45 degree fundus photograph · retinal fundus photograph:
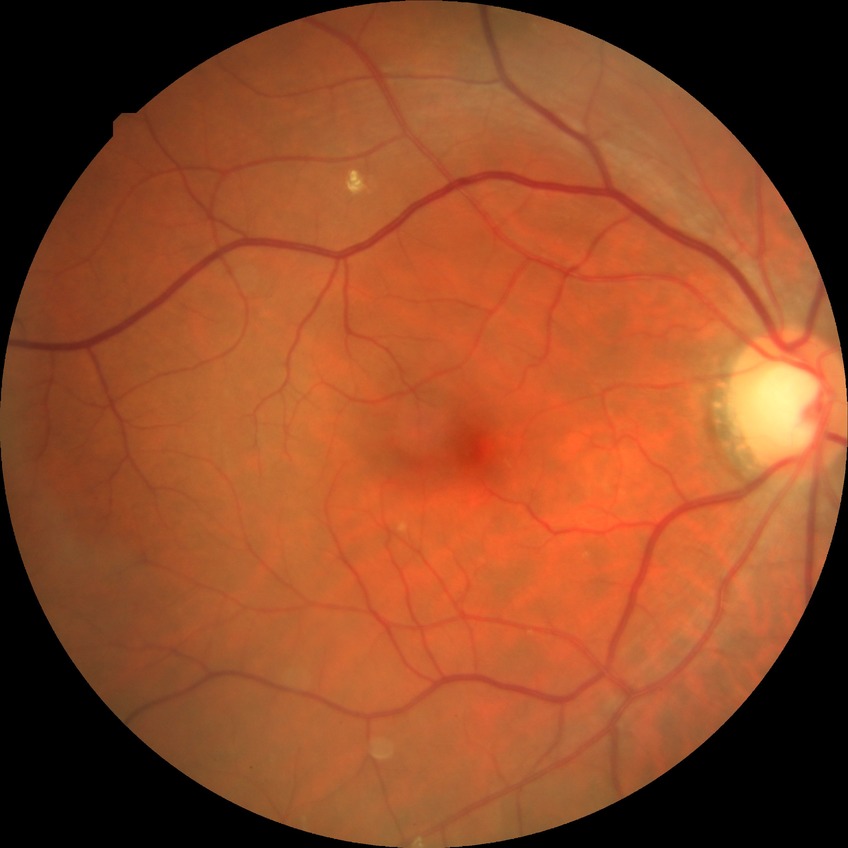 Davis grading: no diabetic retinopathy.